2352x1568px · color fundus image · FOV: 45 degrees: 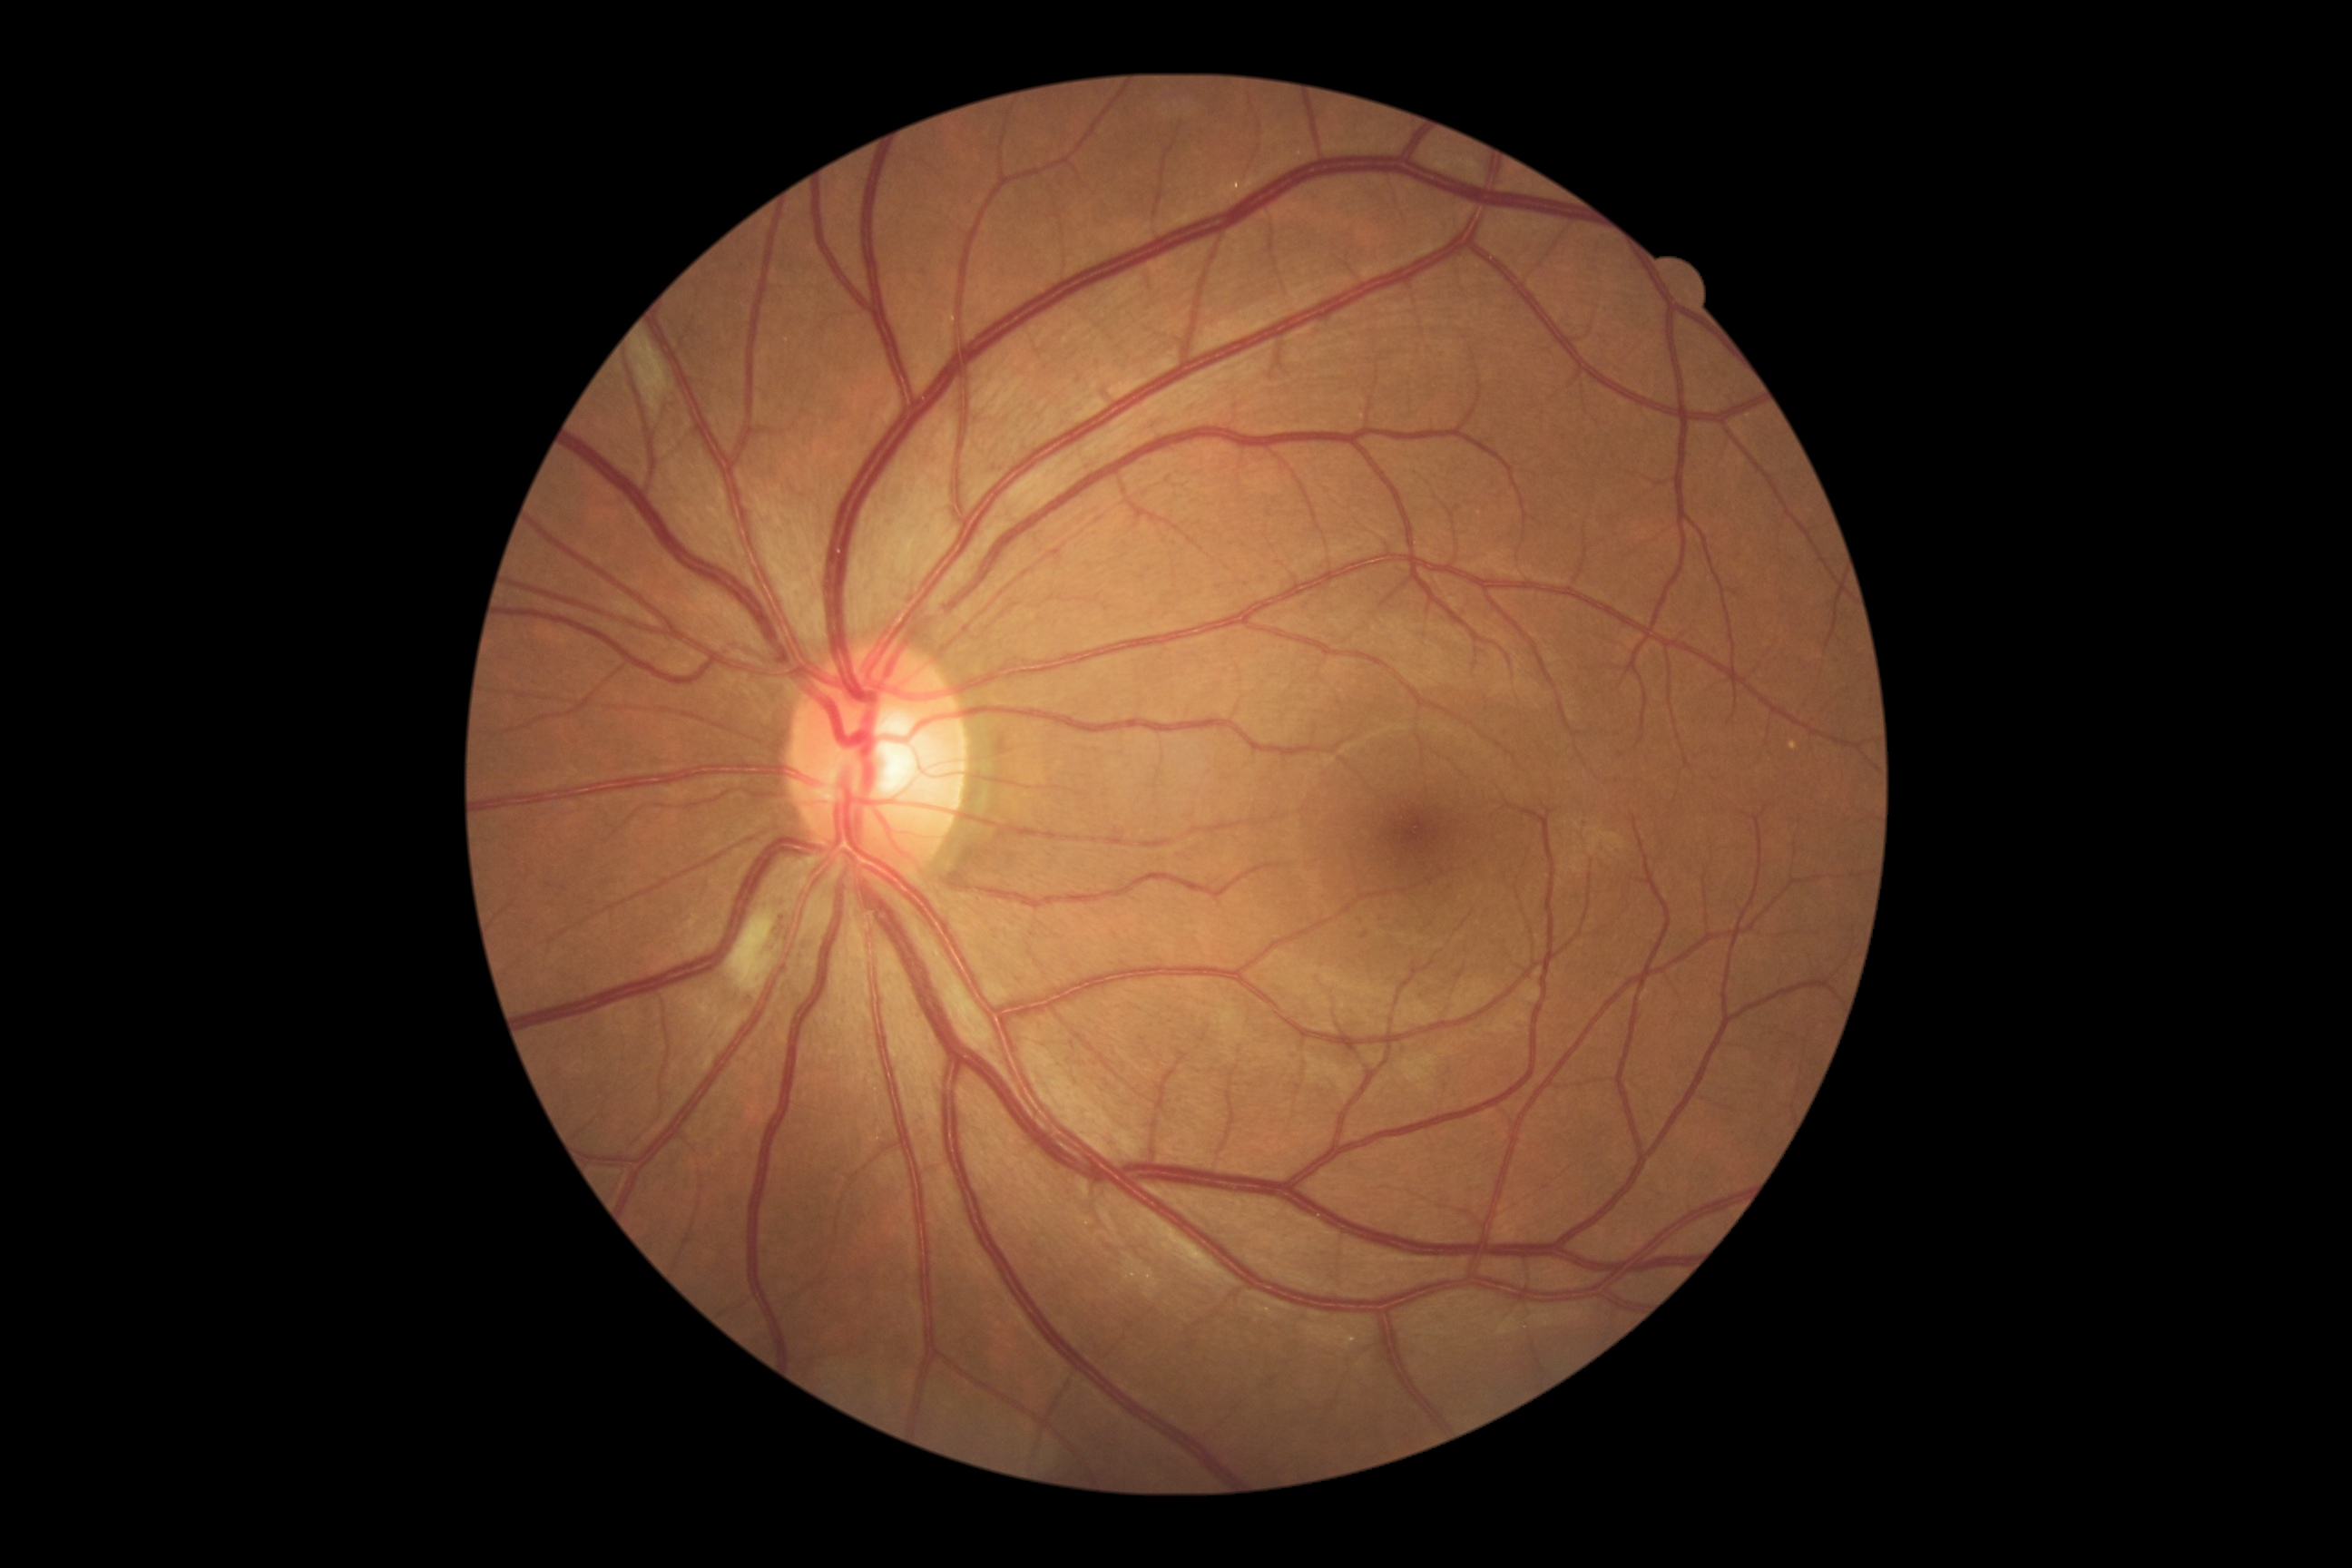
DR stage: 2.